RetCam wide-field infant fundus image: 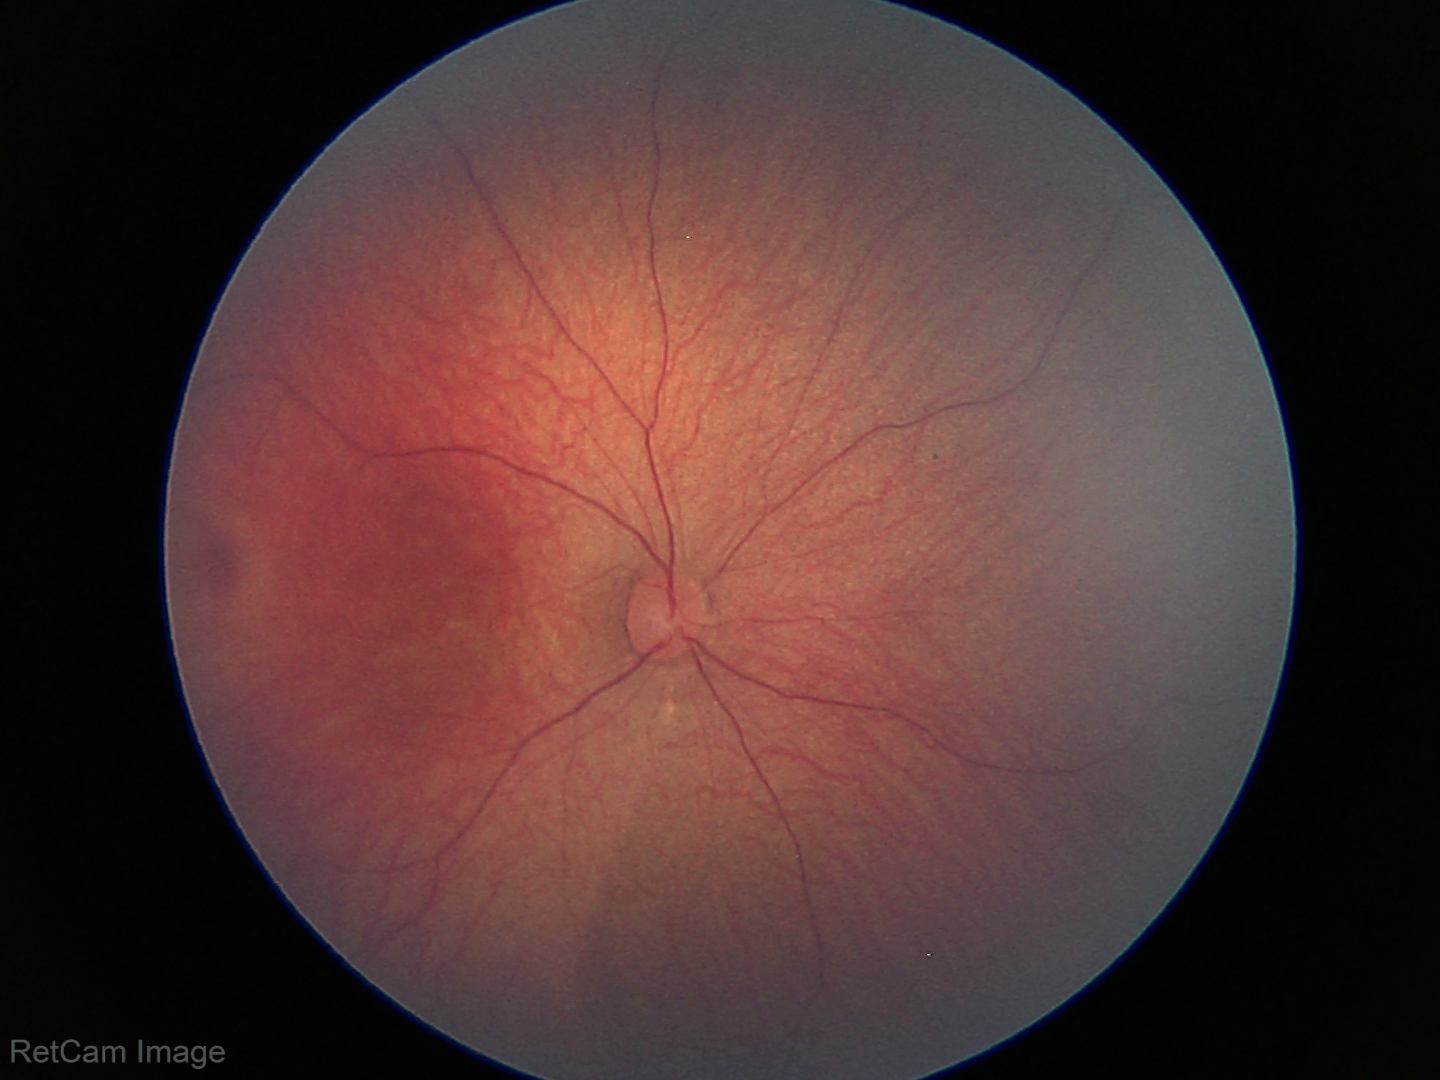
No retinal pathology identified on screening.